Acquired with a NIDEK AFC-230. 45° FOV. Graded on the modified Davis scale. No pharmacologic dilation:
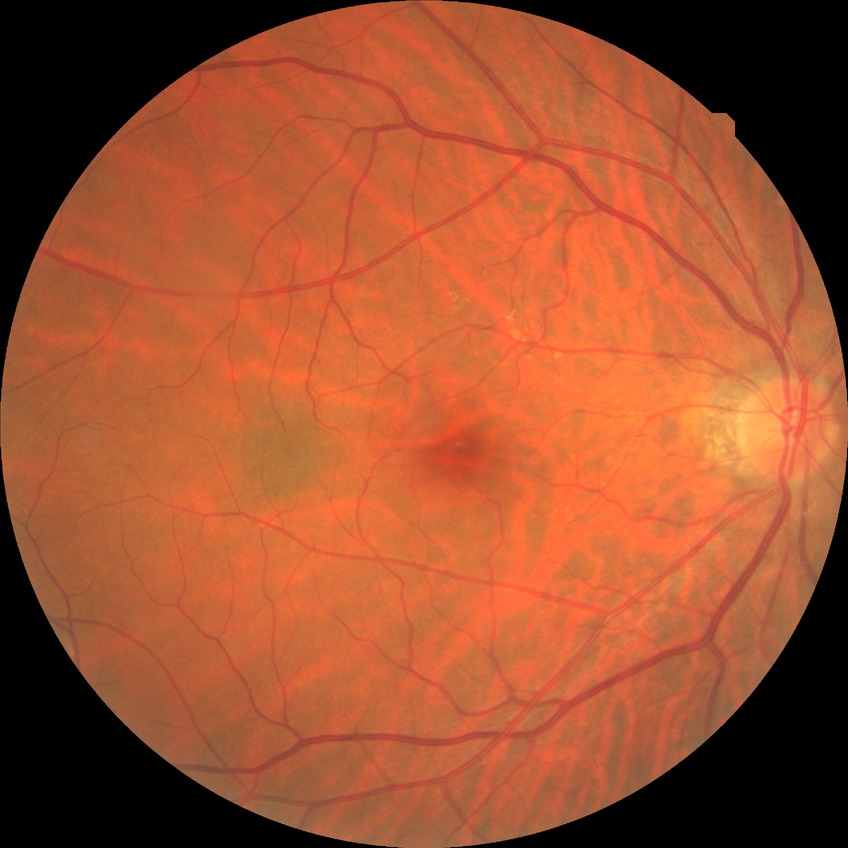 diabetic retinopathy stage: simple diabetic retinopathy.